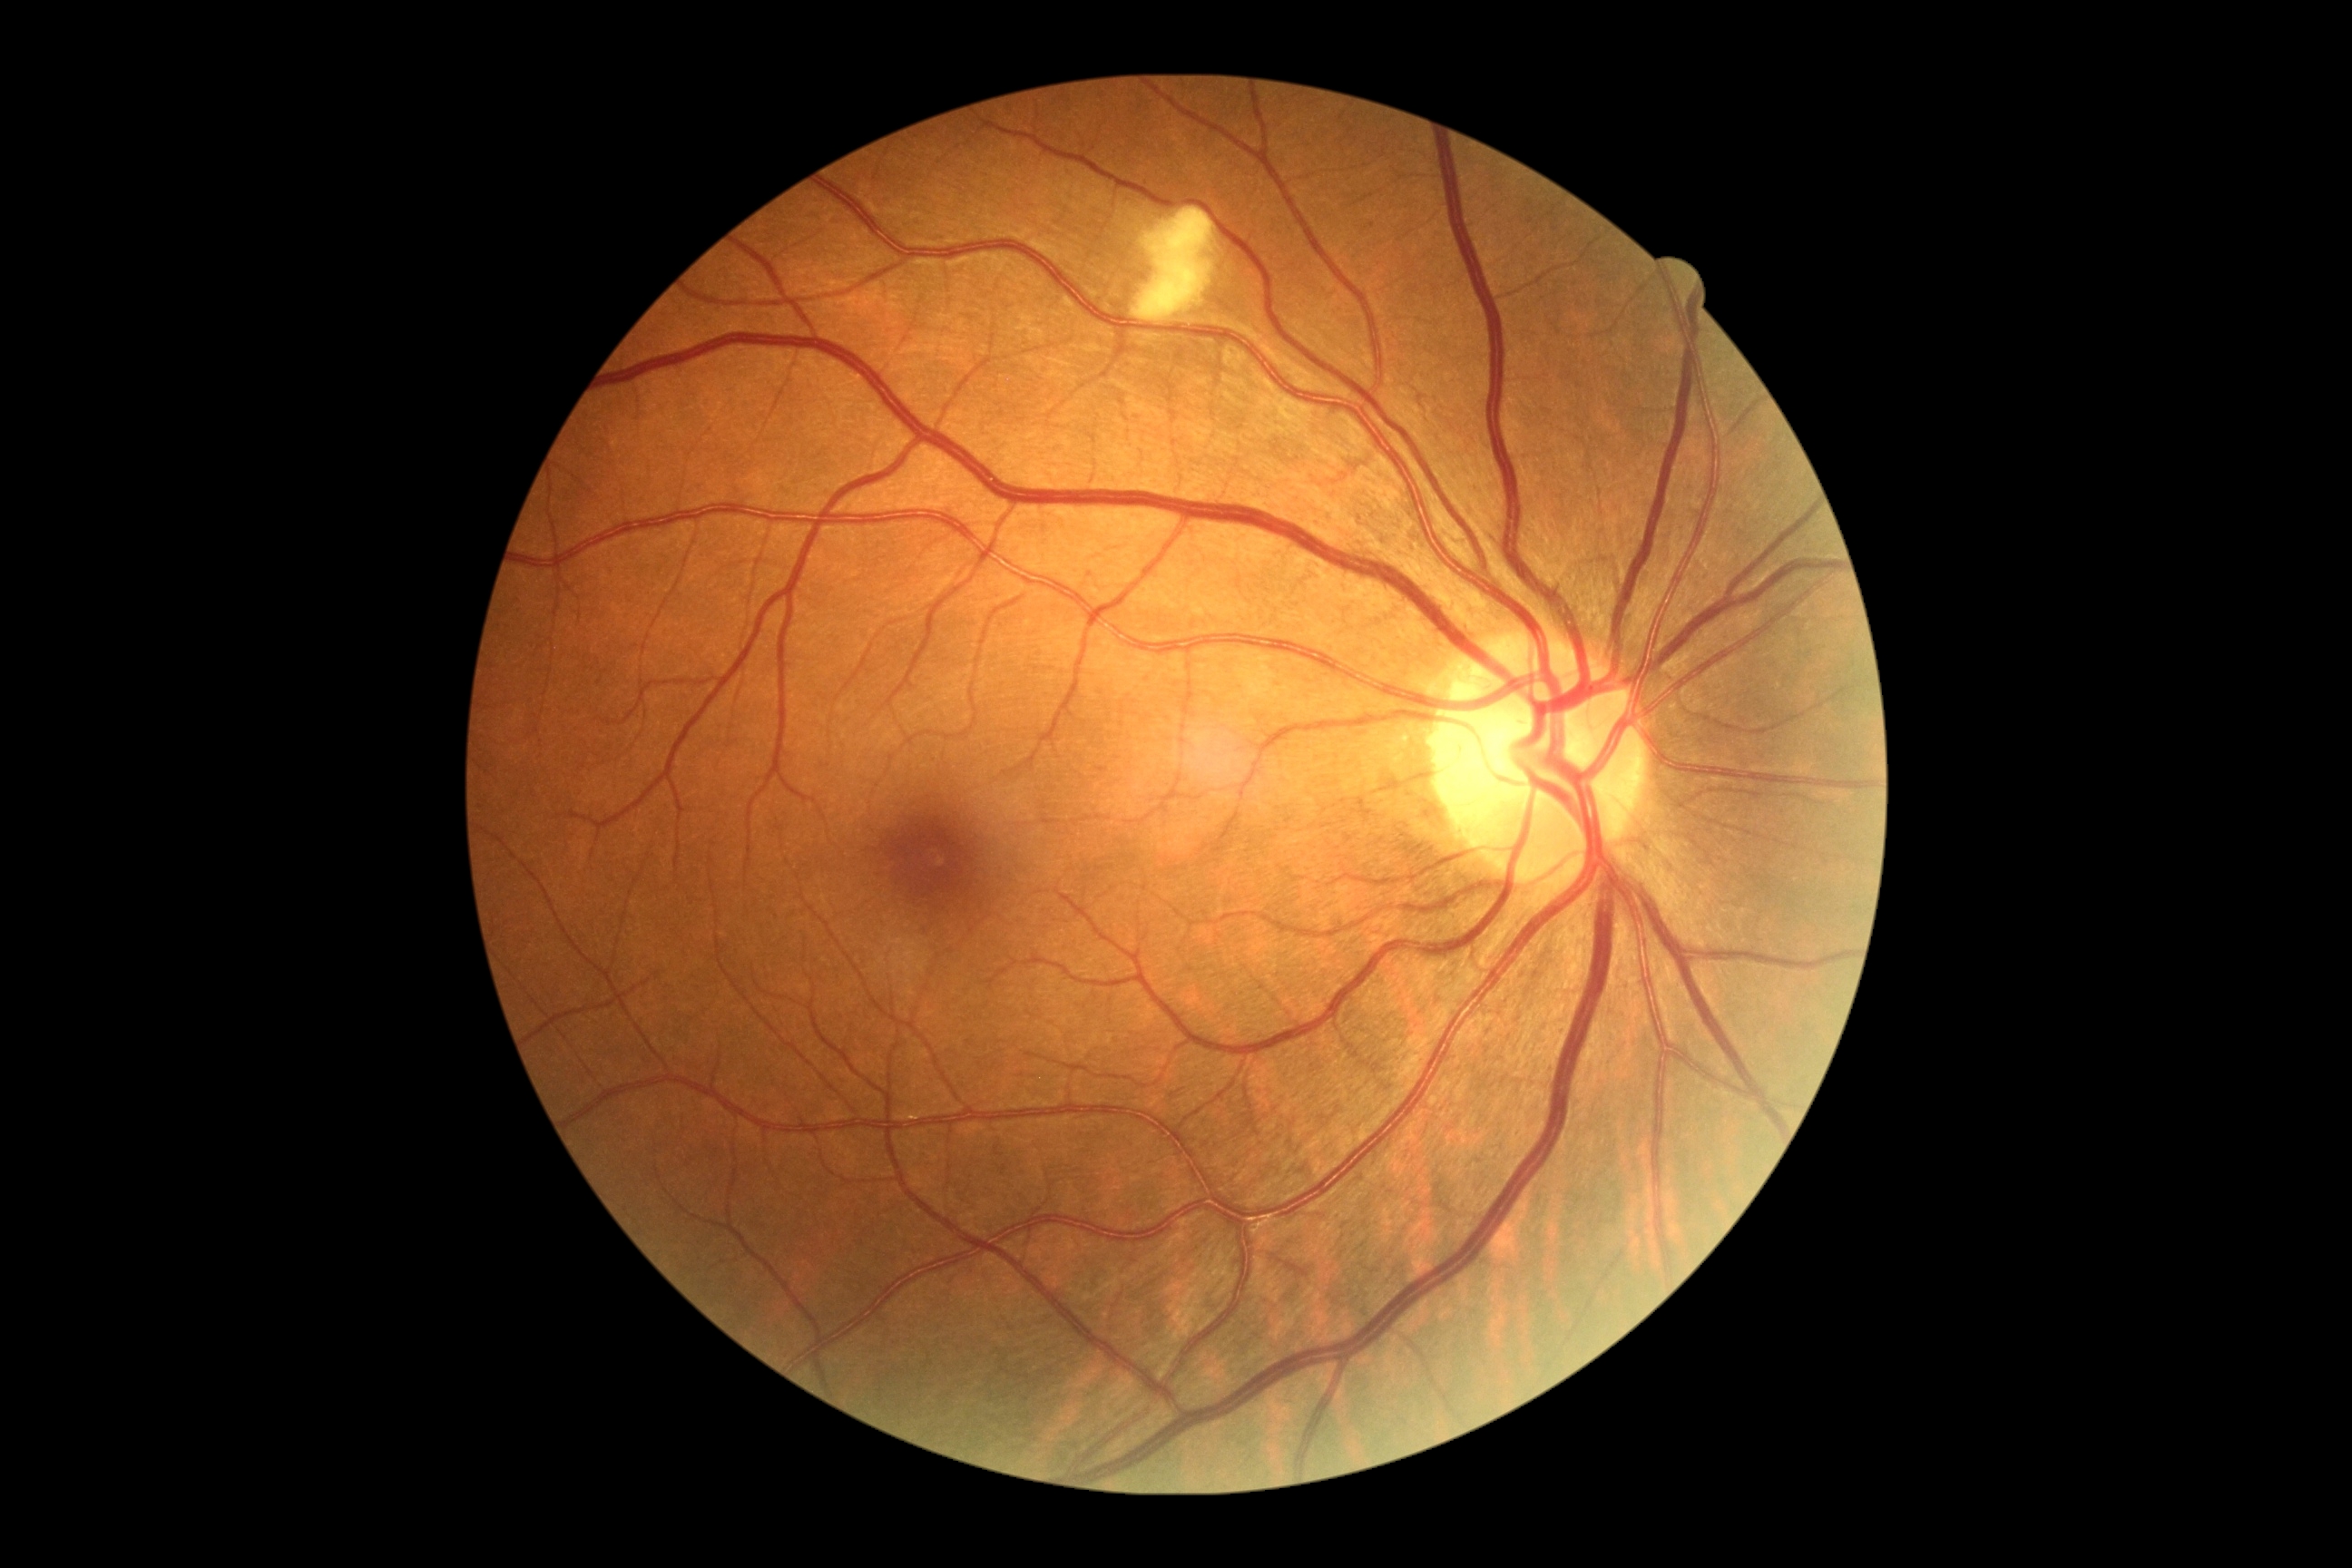

Diabetic retinopathy is moderate NPDR (grade 2).